2352x1568, 45-degree field of view, color fundus photograph
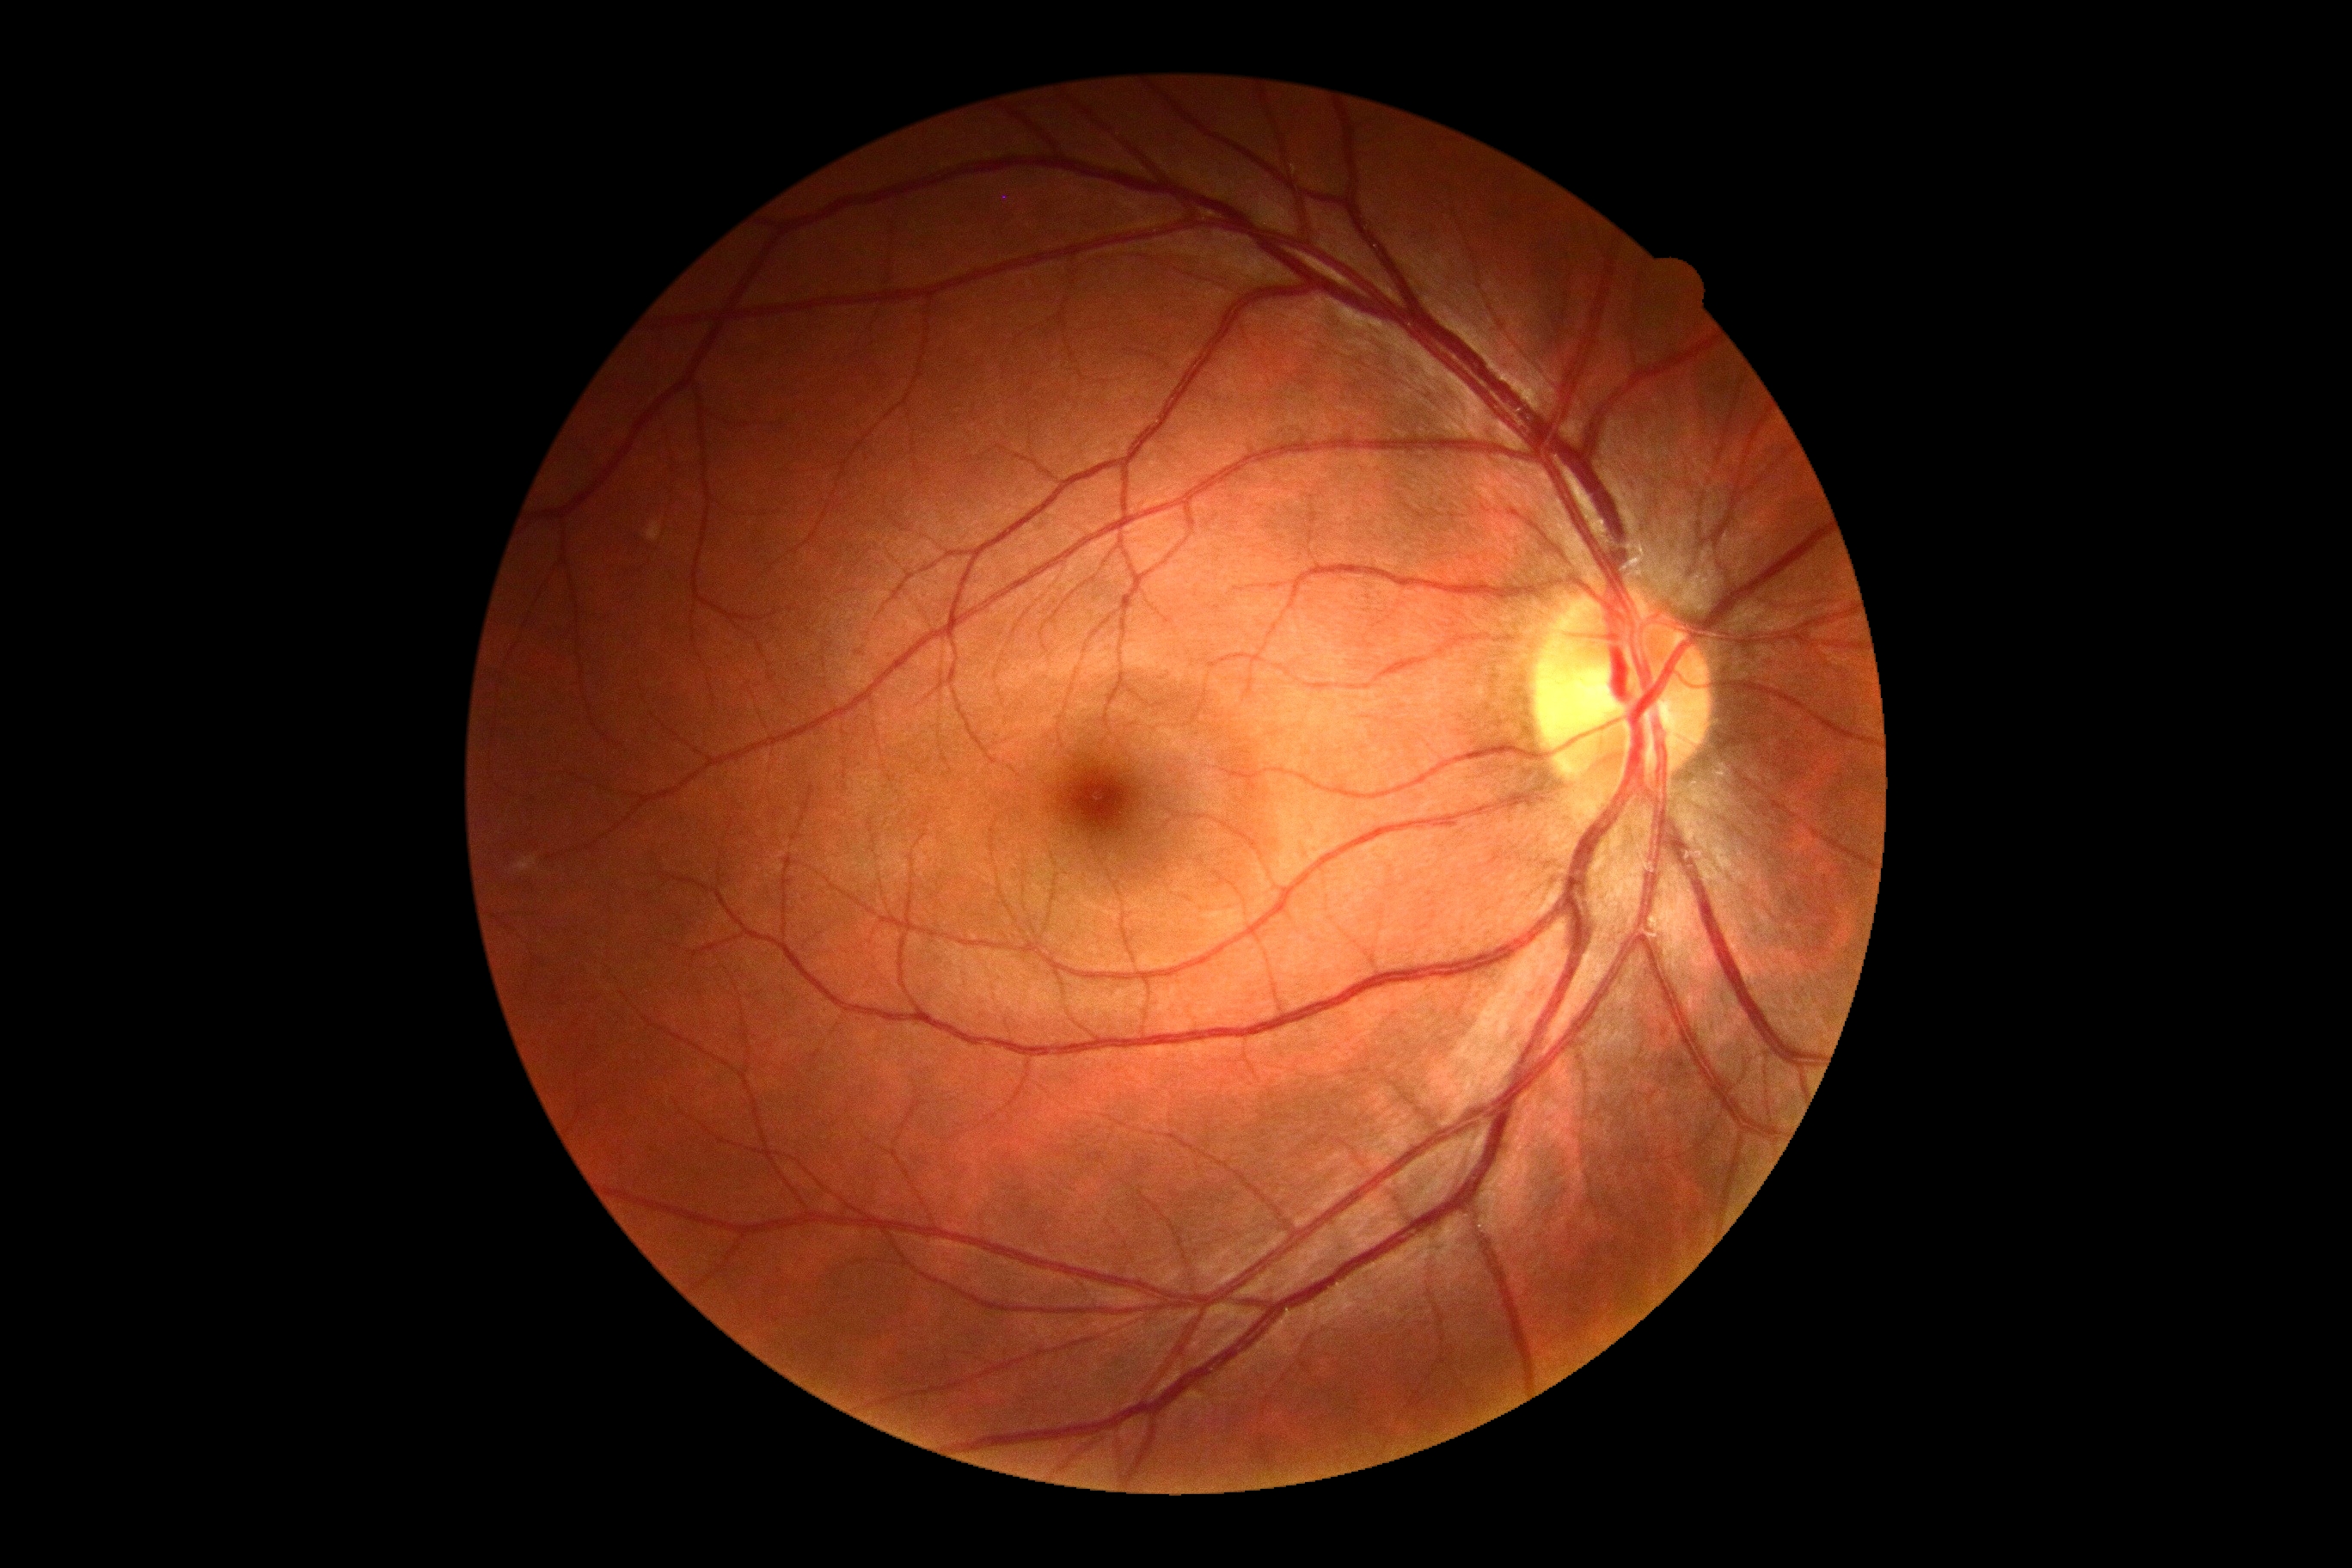
Annotations:
– DR — 0/4